Color fundus photograph:
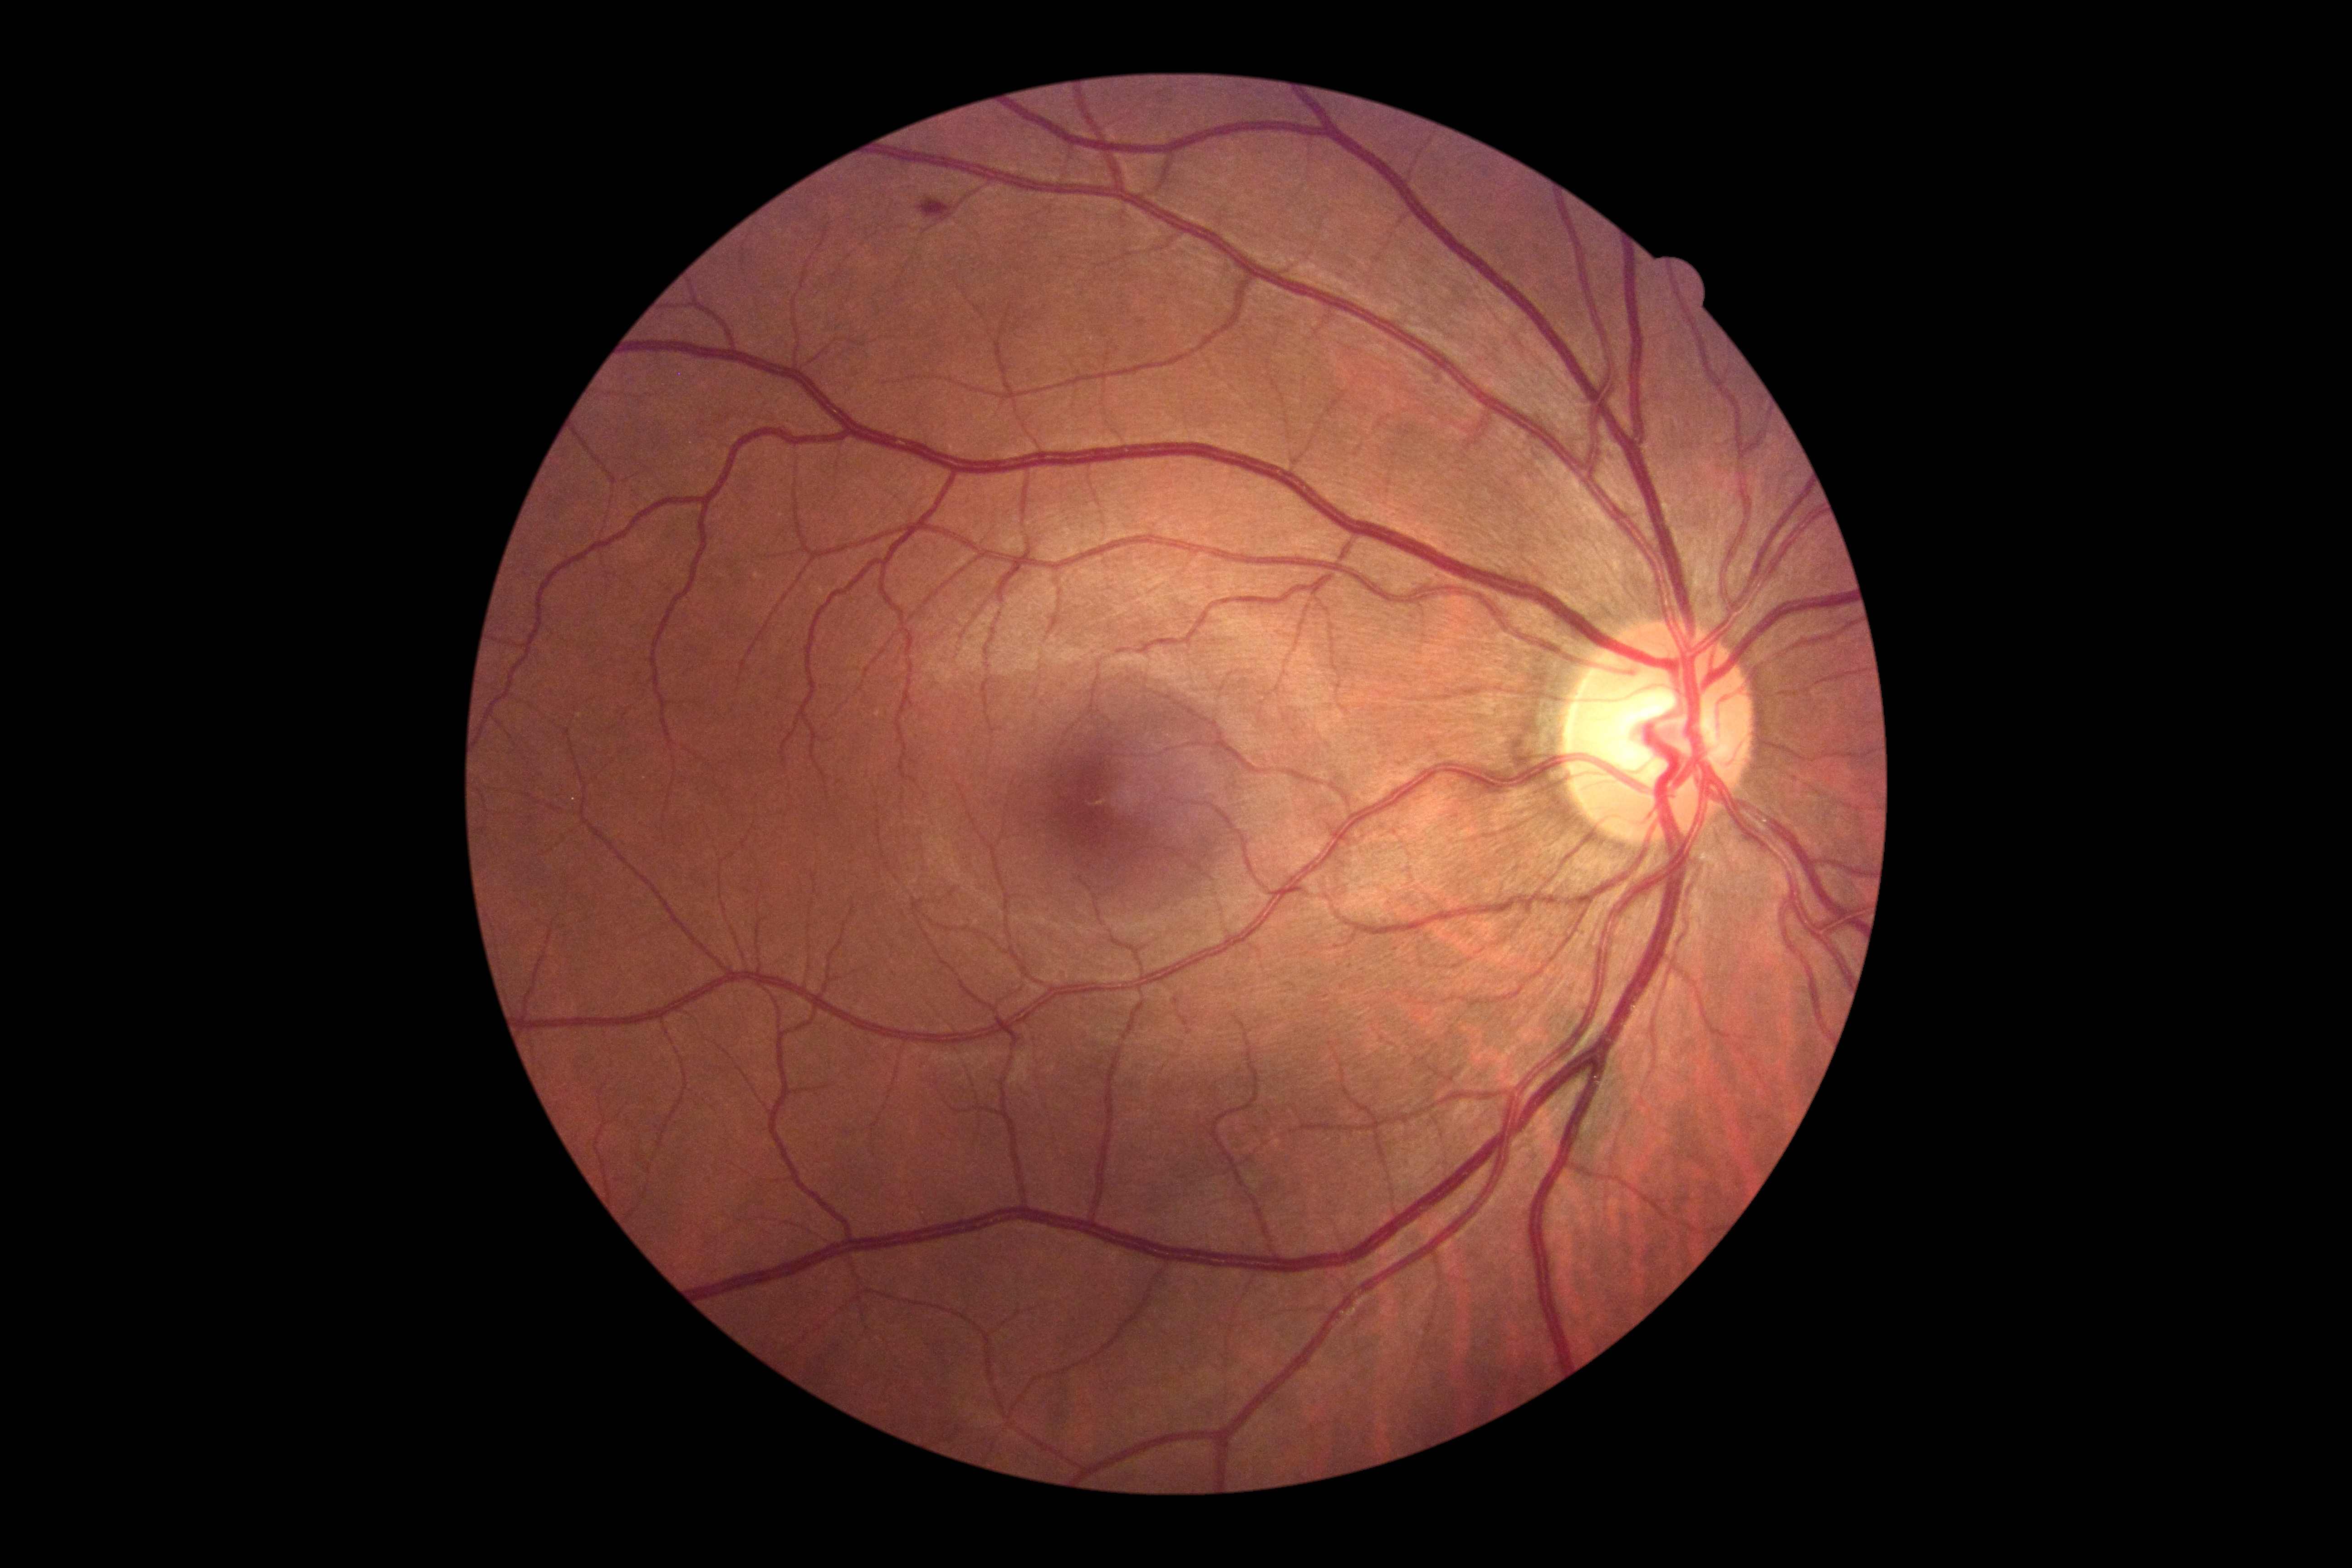 {"dr_grade": 2, "dr_grade_name": "moderate NPDR", "lesions": {"he": [[919, 199, 953, 220]], "ma": null, "ex": null, "se": null}}